45° field of view — 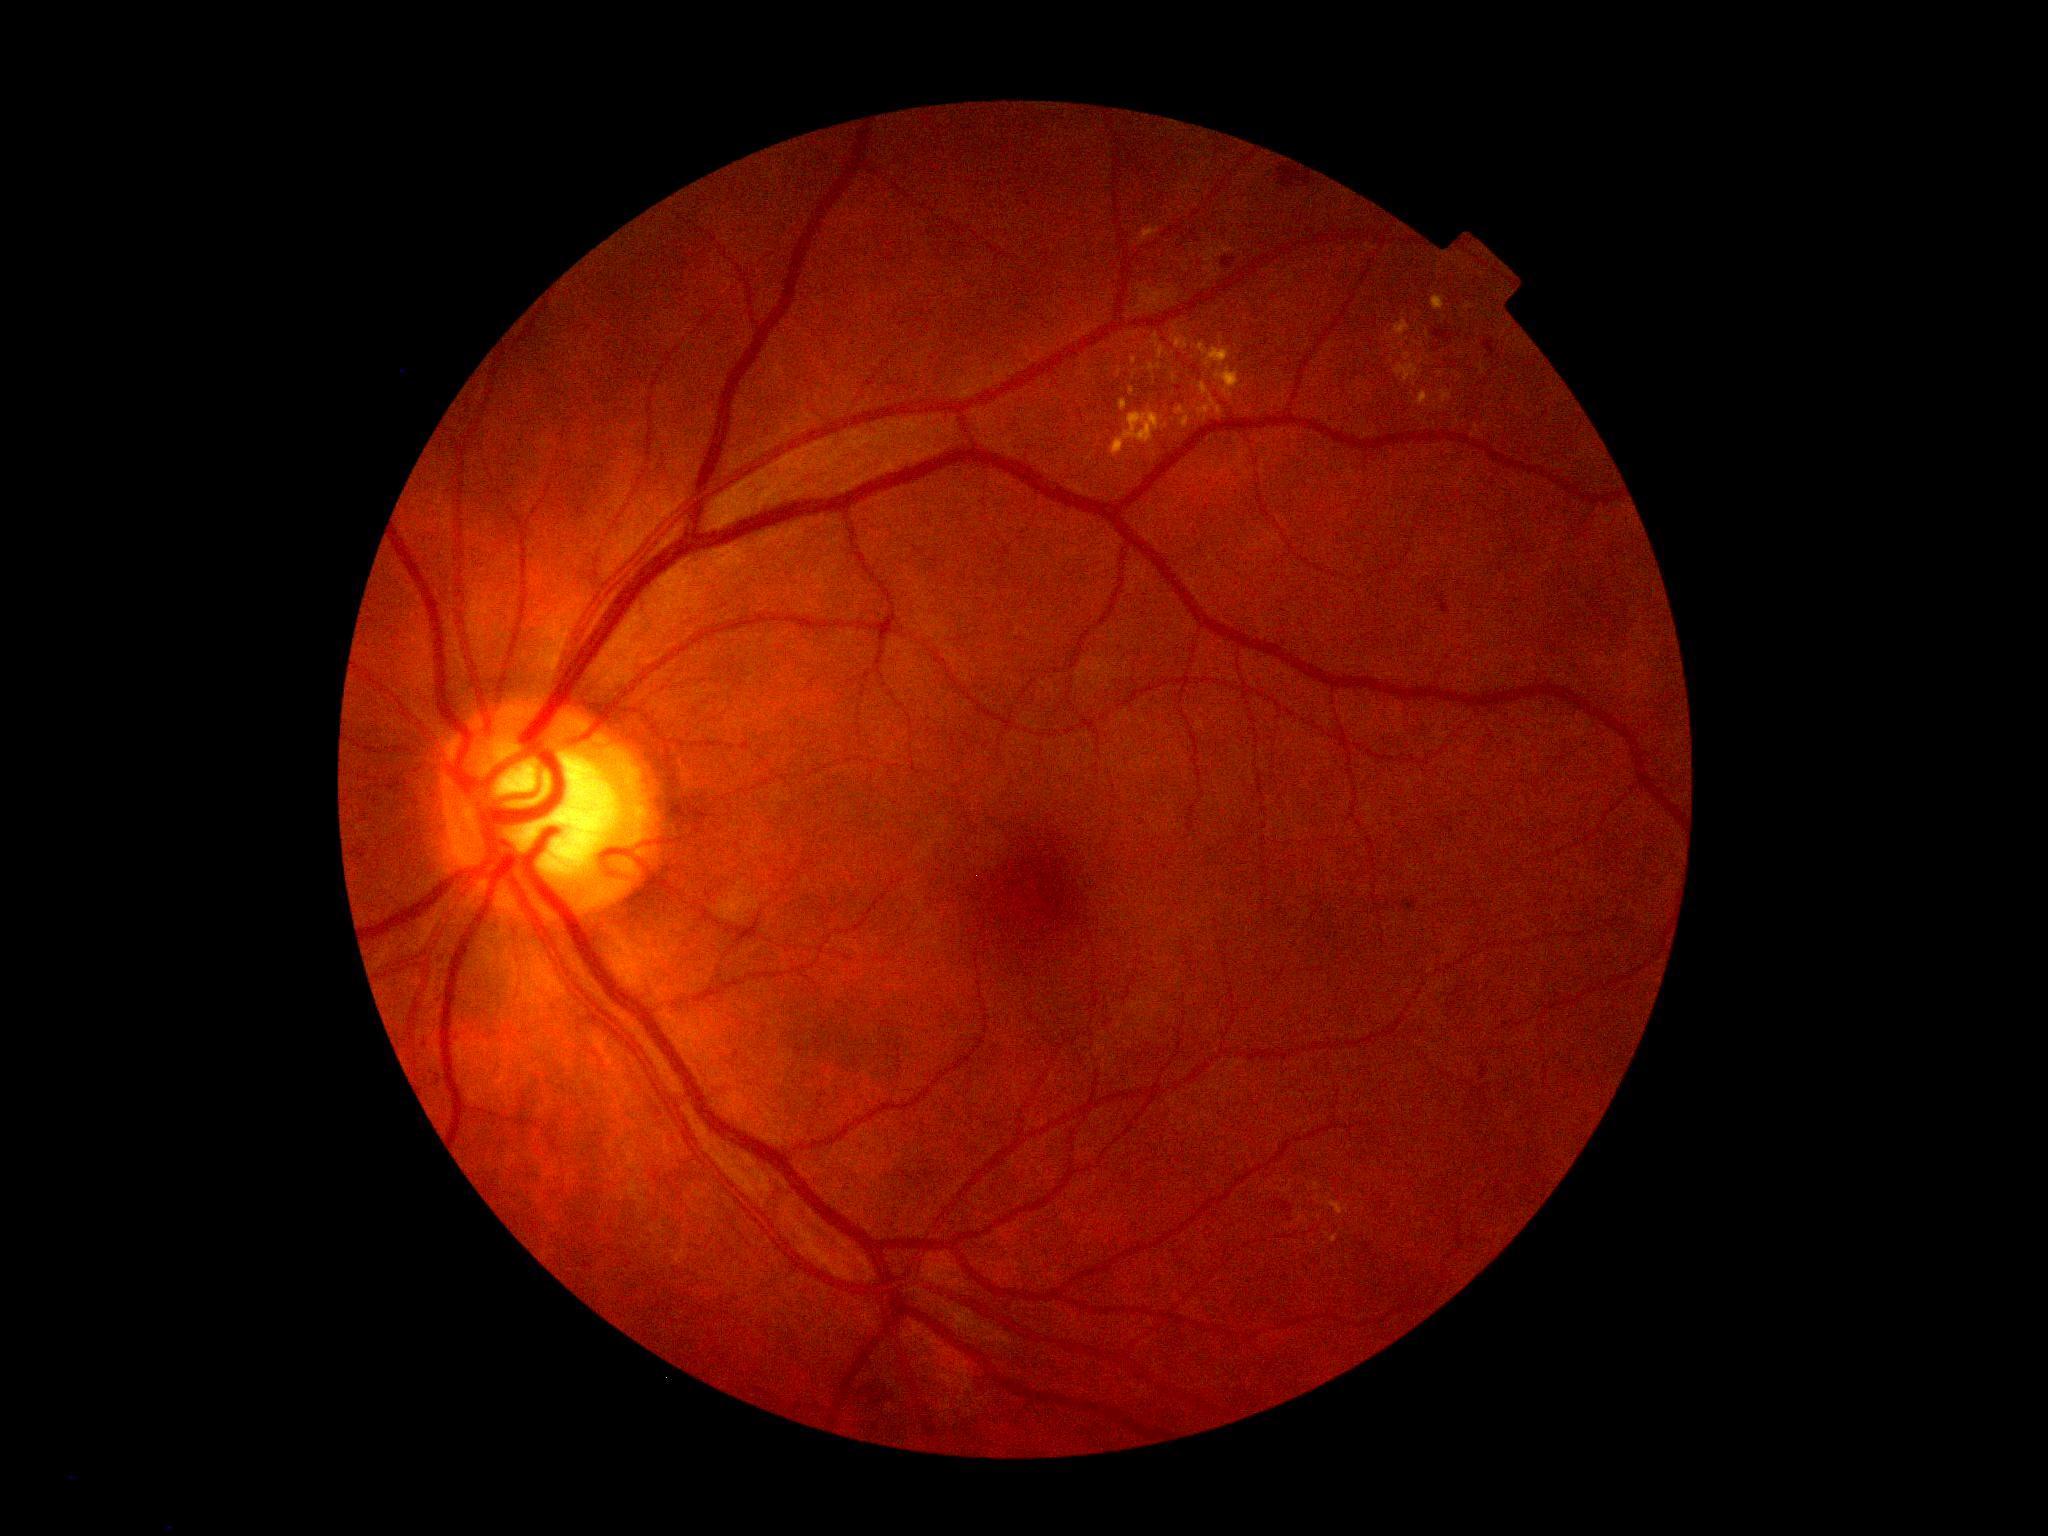

dr_grade: moderate NPDR (grade 2)